2212 x 1659 pixels: 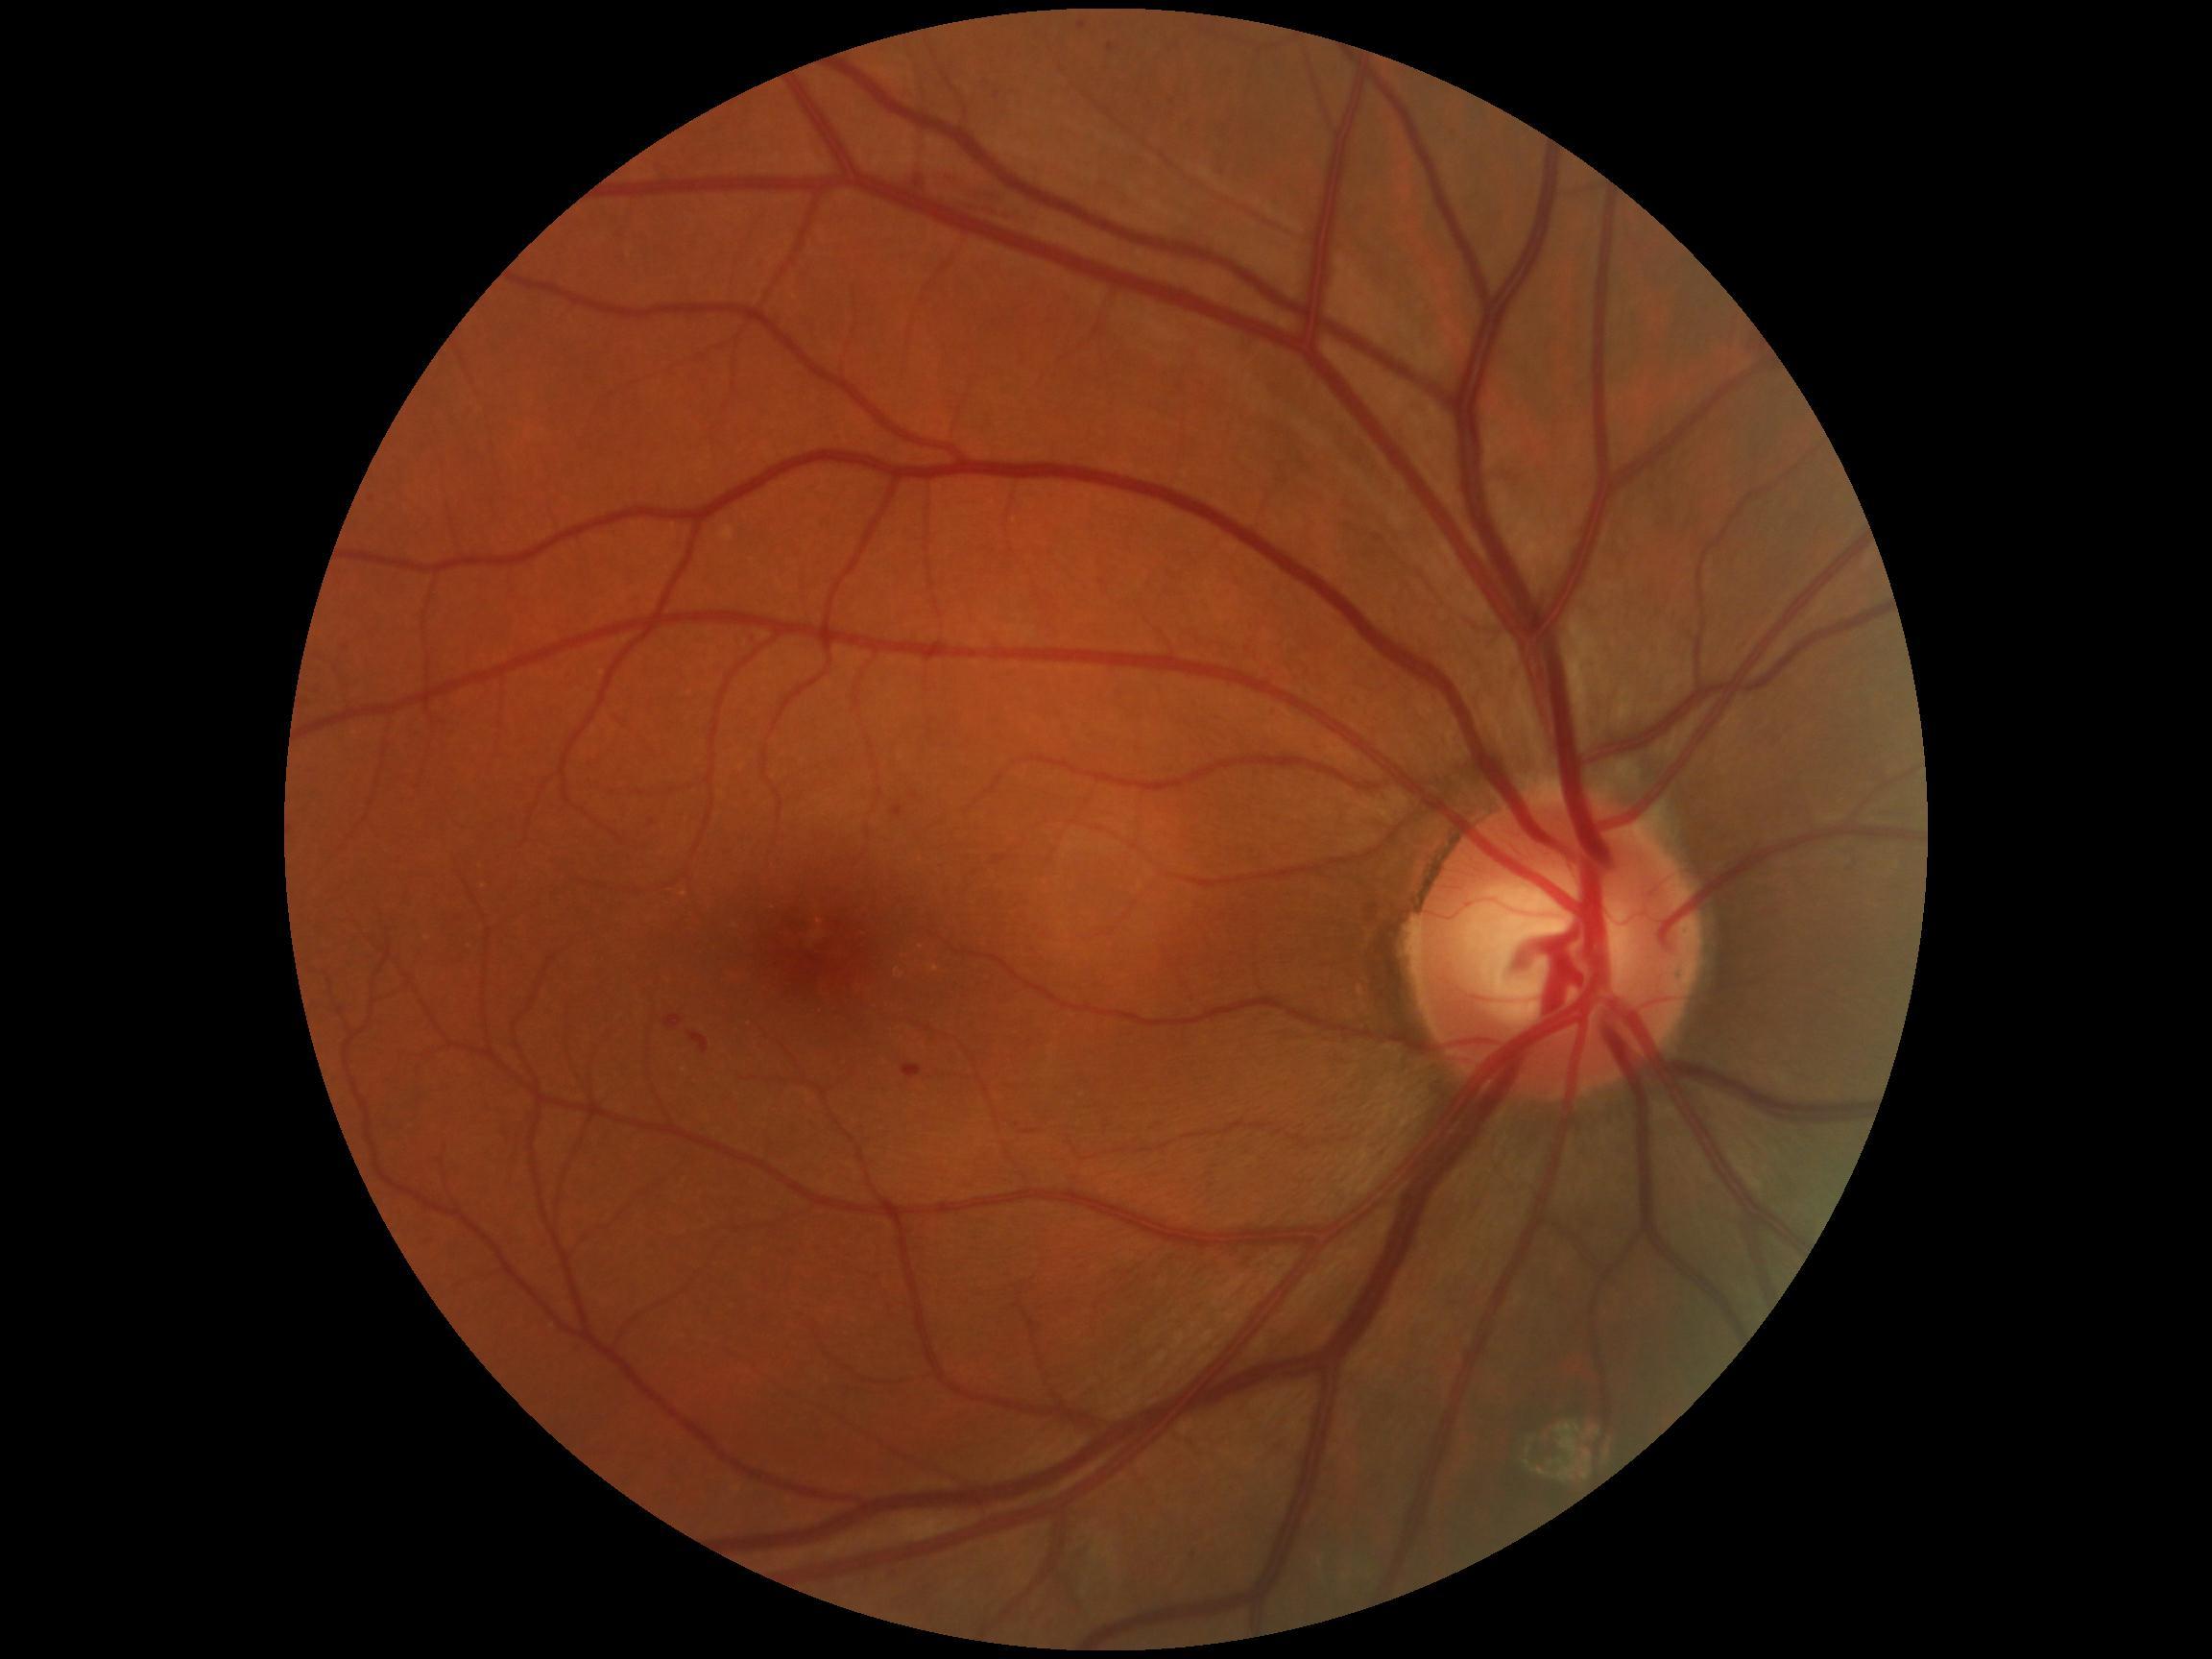 partial: true
dr_grade: 1
lesions:
  he: []
  ma:
    - region(1109, 44, 1114, 52)
    - region(665, 1016, 684, 1030)
    - region(688, 1032, 709, 1054)
    - region(892, 806, 903, 816)
    - region(1078, 21, 1087, 30)
    - region(902, 1066, 923, 1080)
  se: []
  ex: []